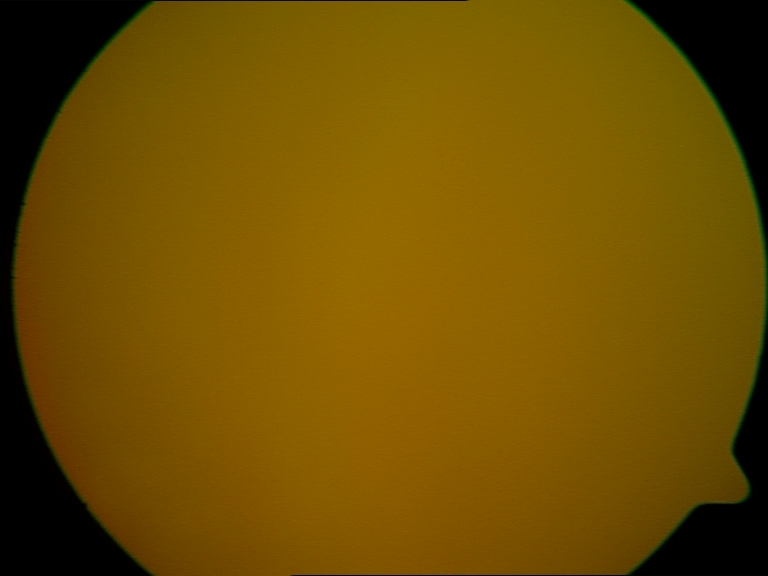 Gradability: significantly degraded.
Proliferative retinopathy: negative.